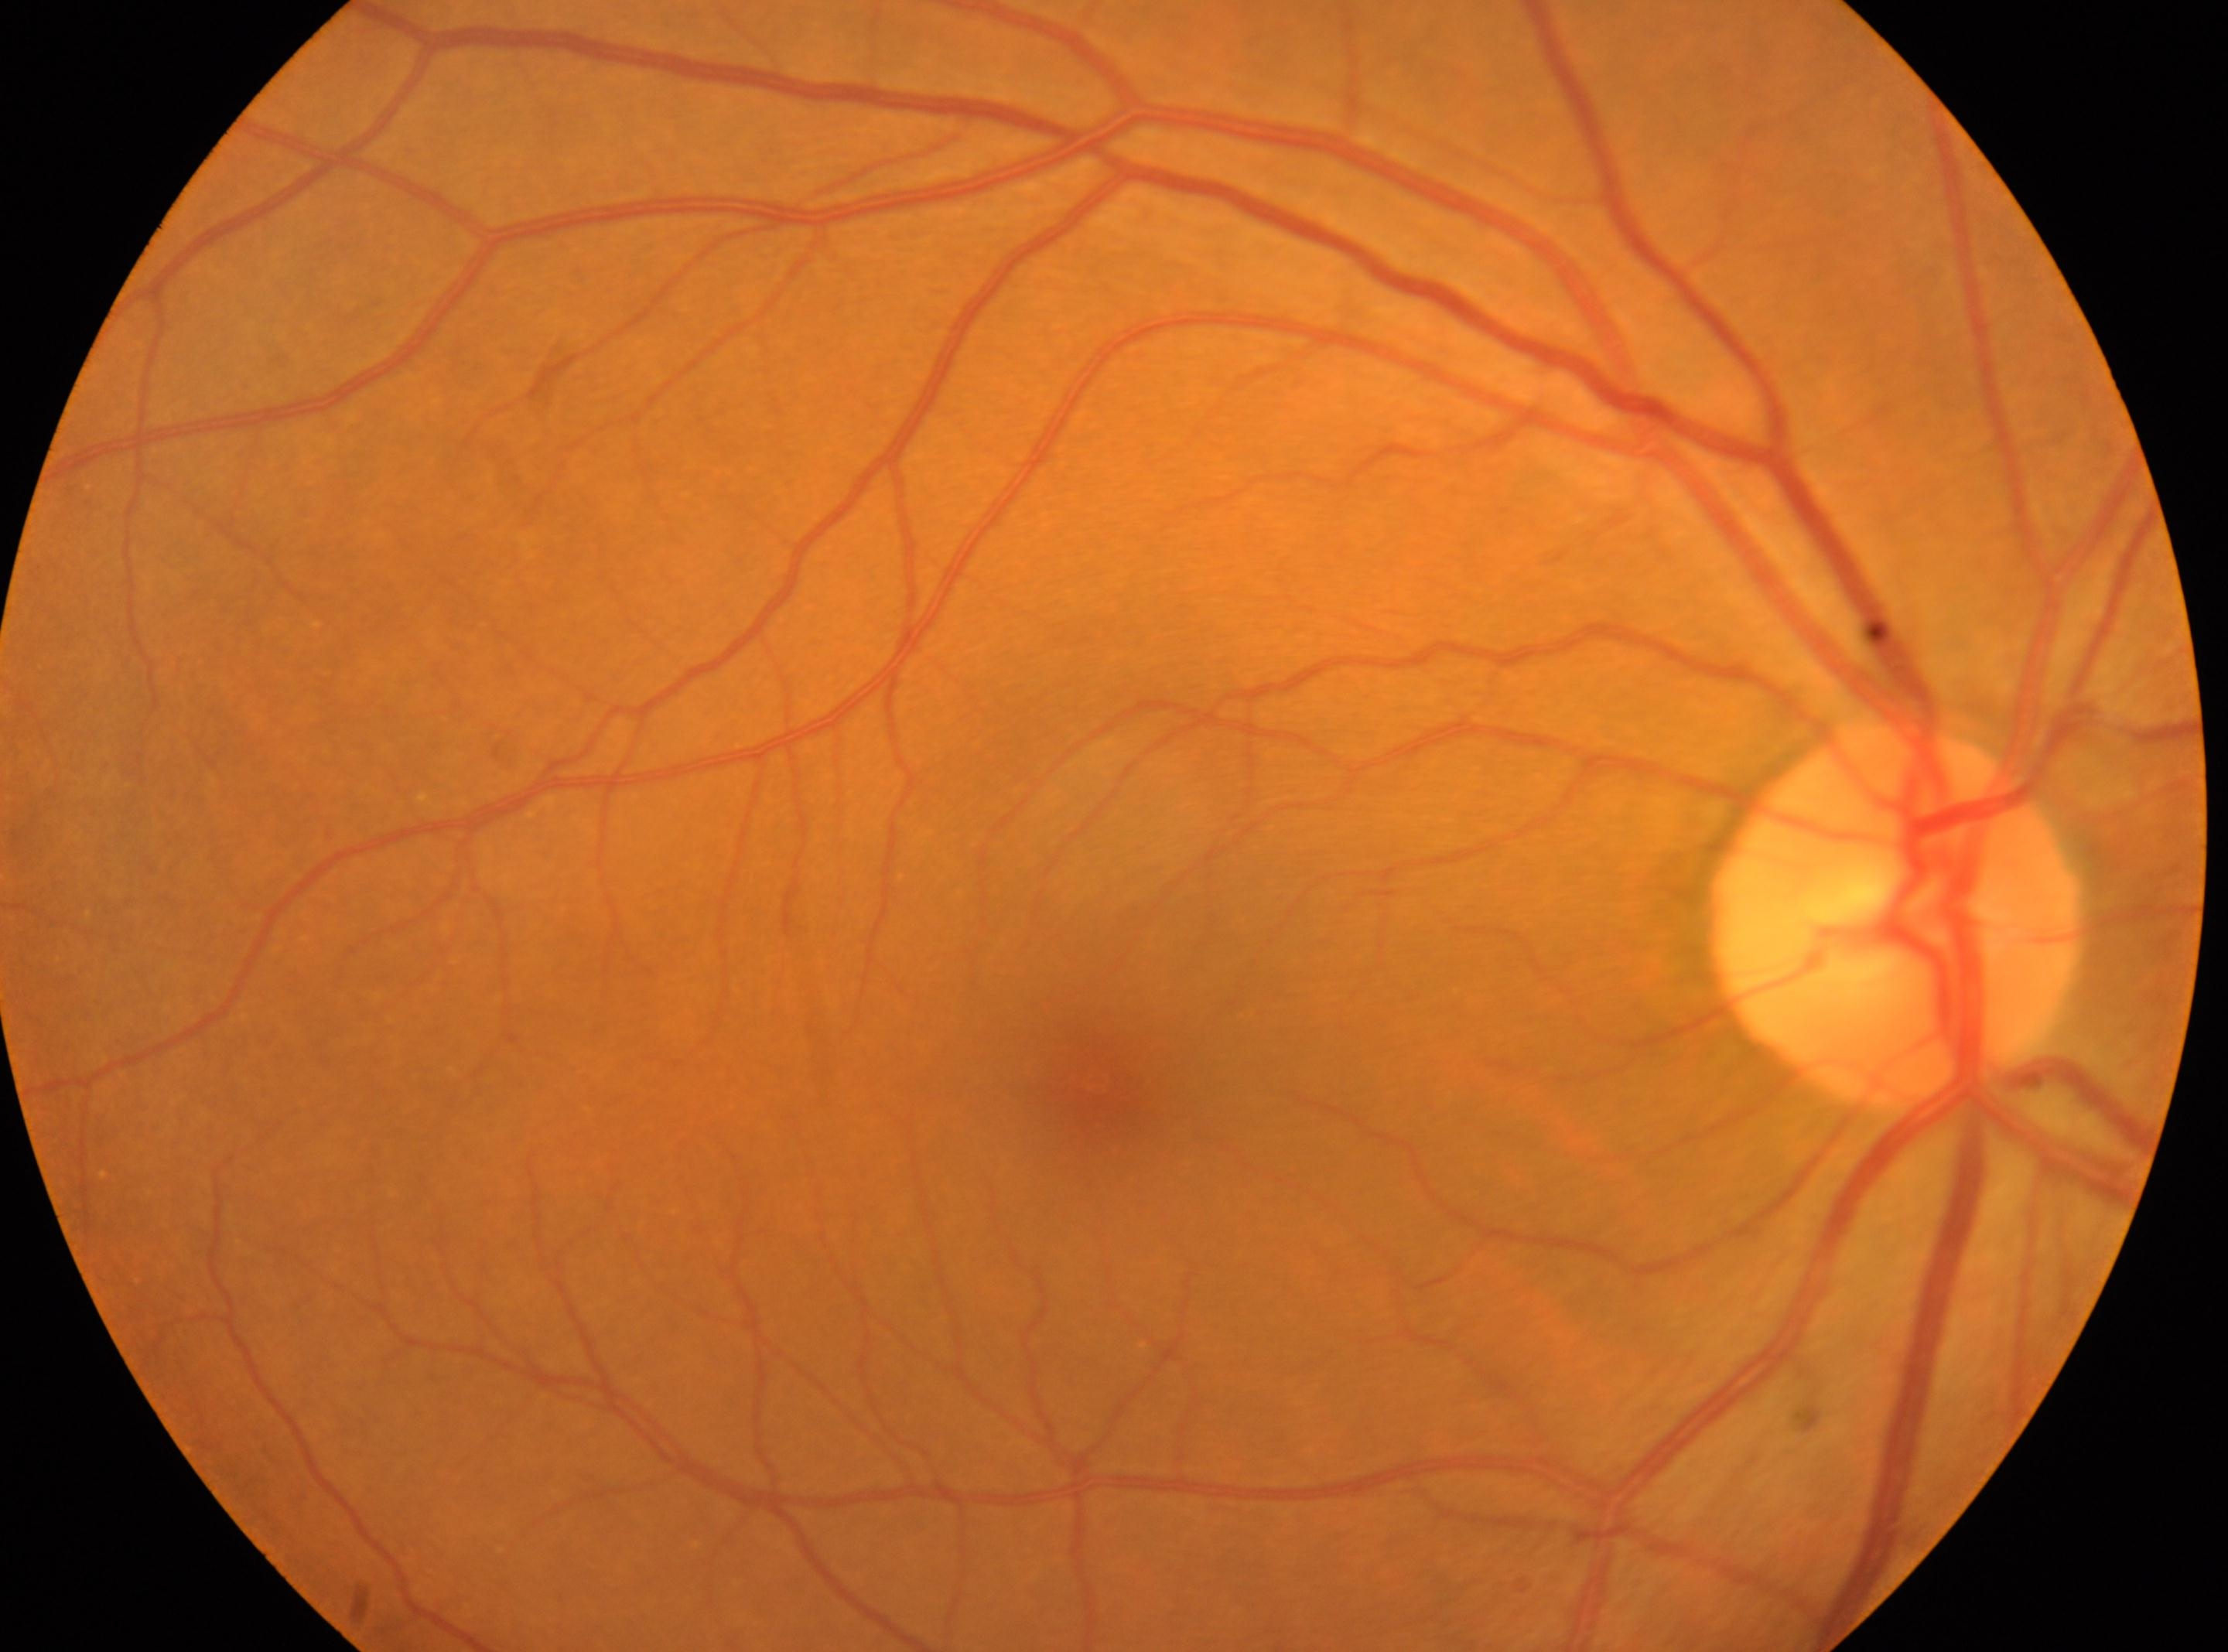
No diabetic retinal disease findings. Optic nerve head: (x=1895, y=916). Imaged eye: the right eye. The foveal center is at (x=1095, y=1081). Diabetic retinopathy (DR): no apparent retinopathy (grade 0).